Nonmydriatic; 848x848px.
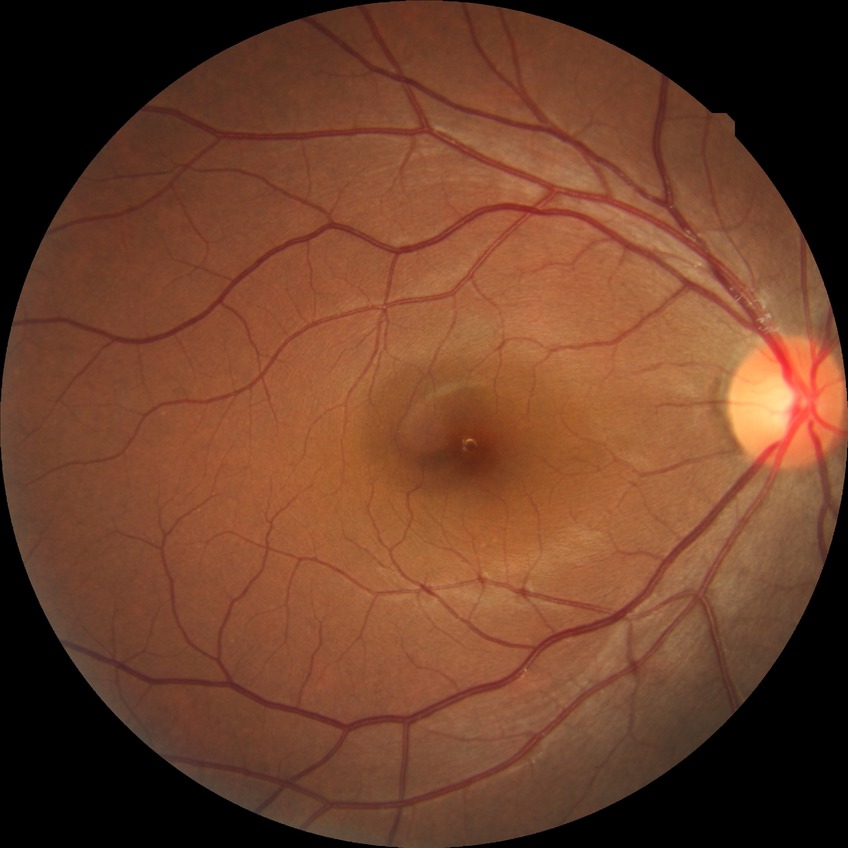
Diabetic retinopathy (DR) is no diabetic retinopathy (NDR).